FOV: 45 degrees; fundus photo; 848 x 848 pixels.
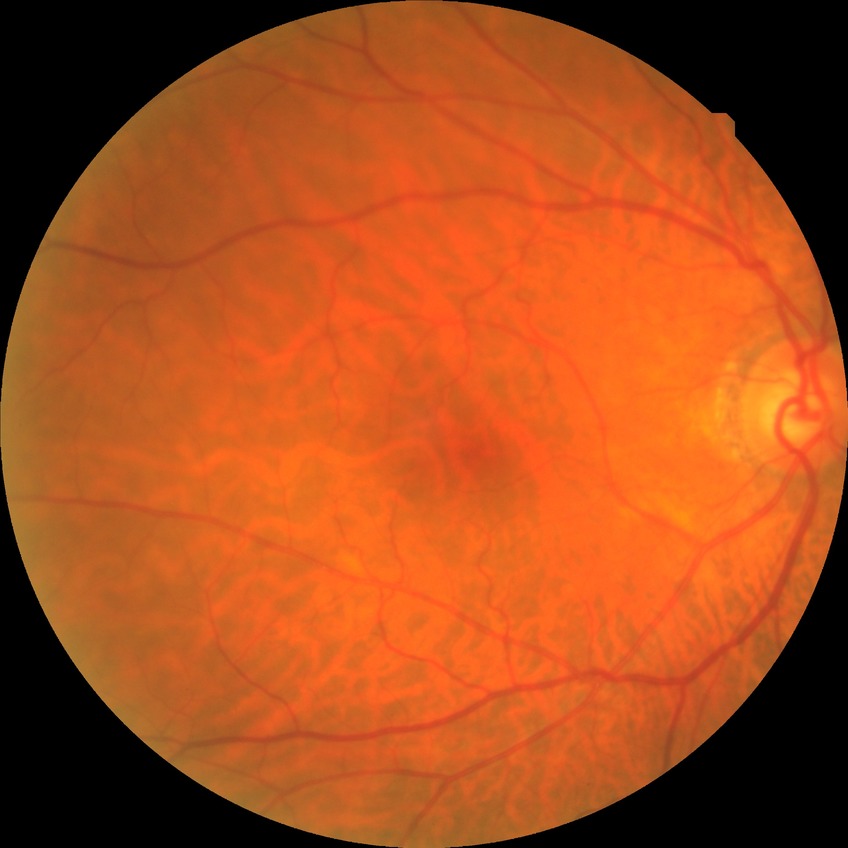
Modified Davis grading: no diabetic retinopathy.